Non-mydriatic. Cropped to the optic nerve head. Camera: Nidek AFC-330.
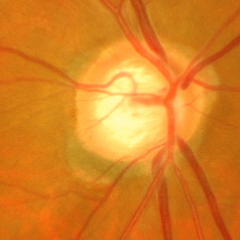 Findings consistent with glaucoma. Glaucoma assessment = early glaucomatous optic neuropathy.